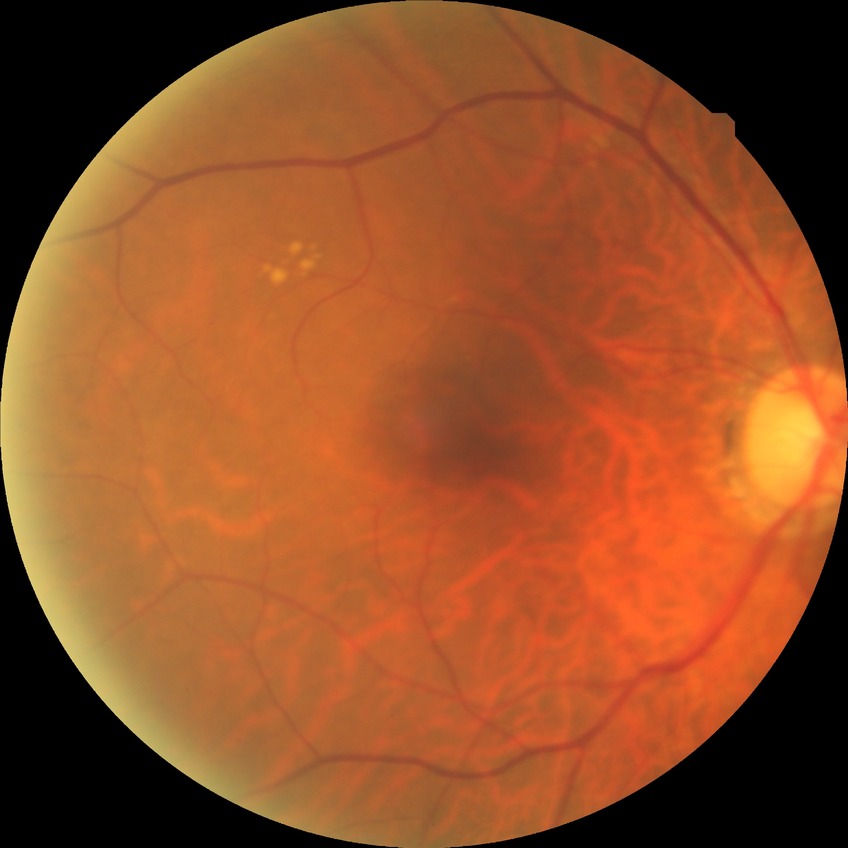
Diabetic retinopathy (DR): NDR (no diabetic retinopathy).